Modified Davis grading: 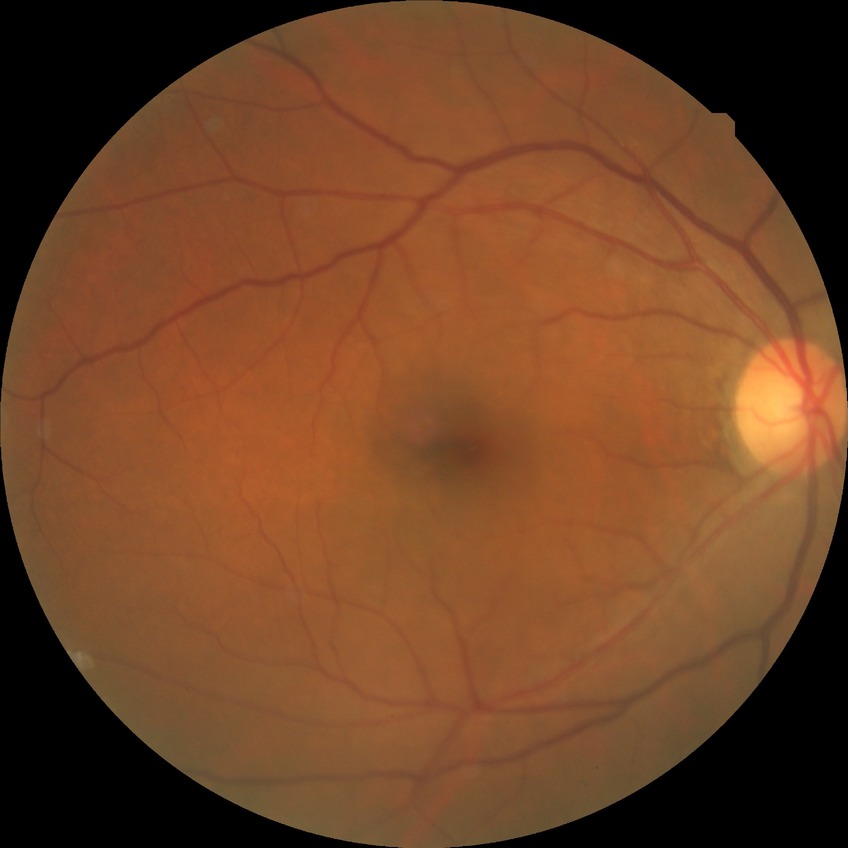

{
  "davis_grade": "no diabetic retinopathy"
}